NIDEK AFC-230. 45 degree fundus photograph. 848 x 848 pixels — 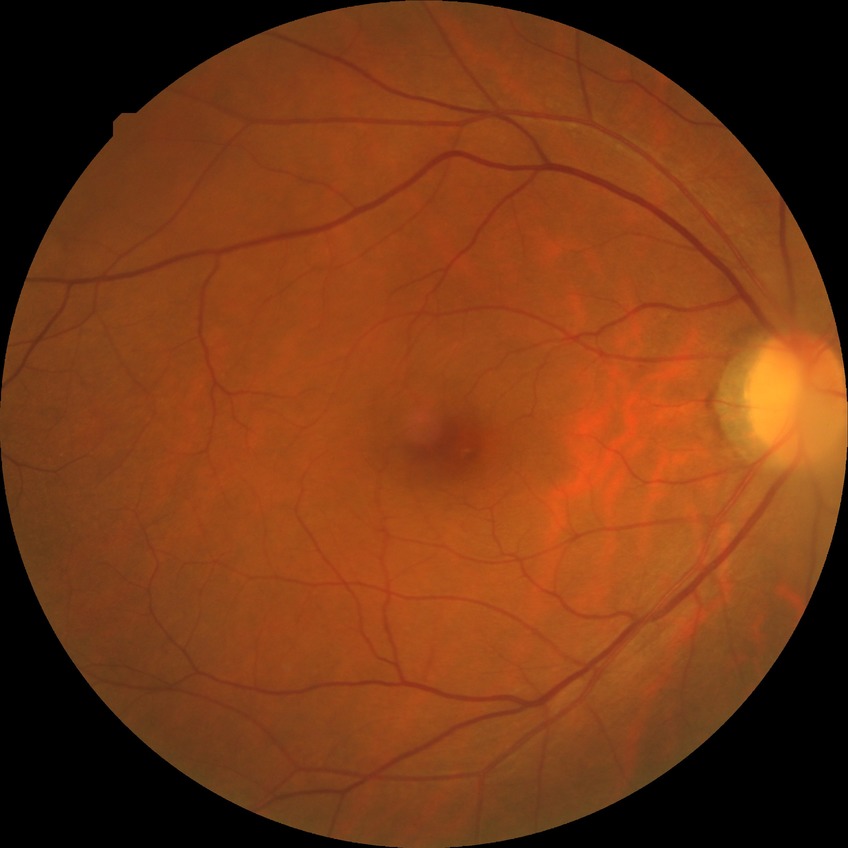 No apparent diabetic retinopathy.
Modified Davis grade is NDR.